961 by 961 pixels, optic disc photograph.
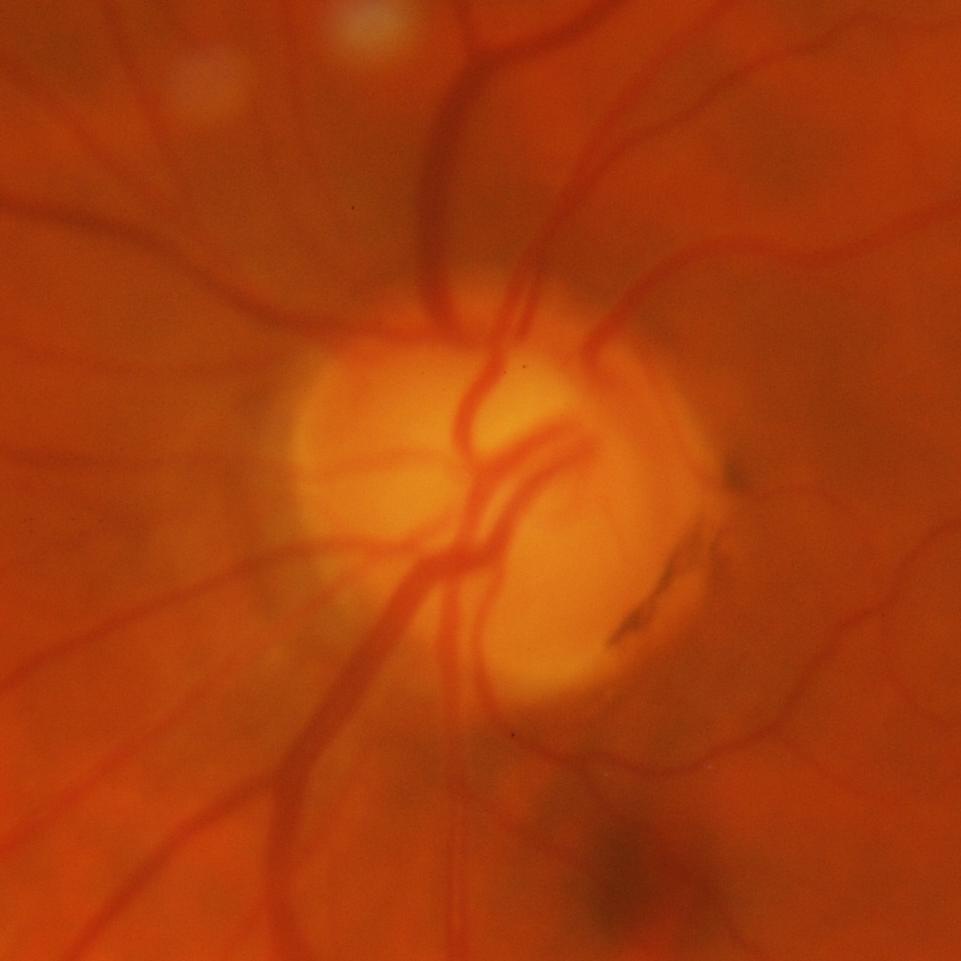

Glaucoma is present.
Glaucomatous optic neuropathy.